2352 by 1568 pixels. Retinal fundus photograph
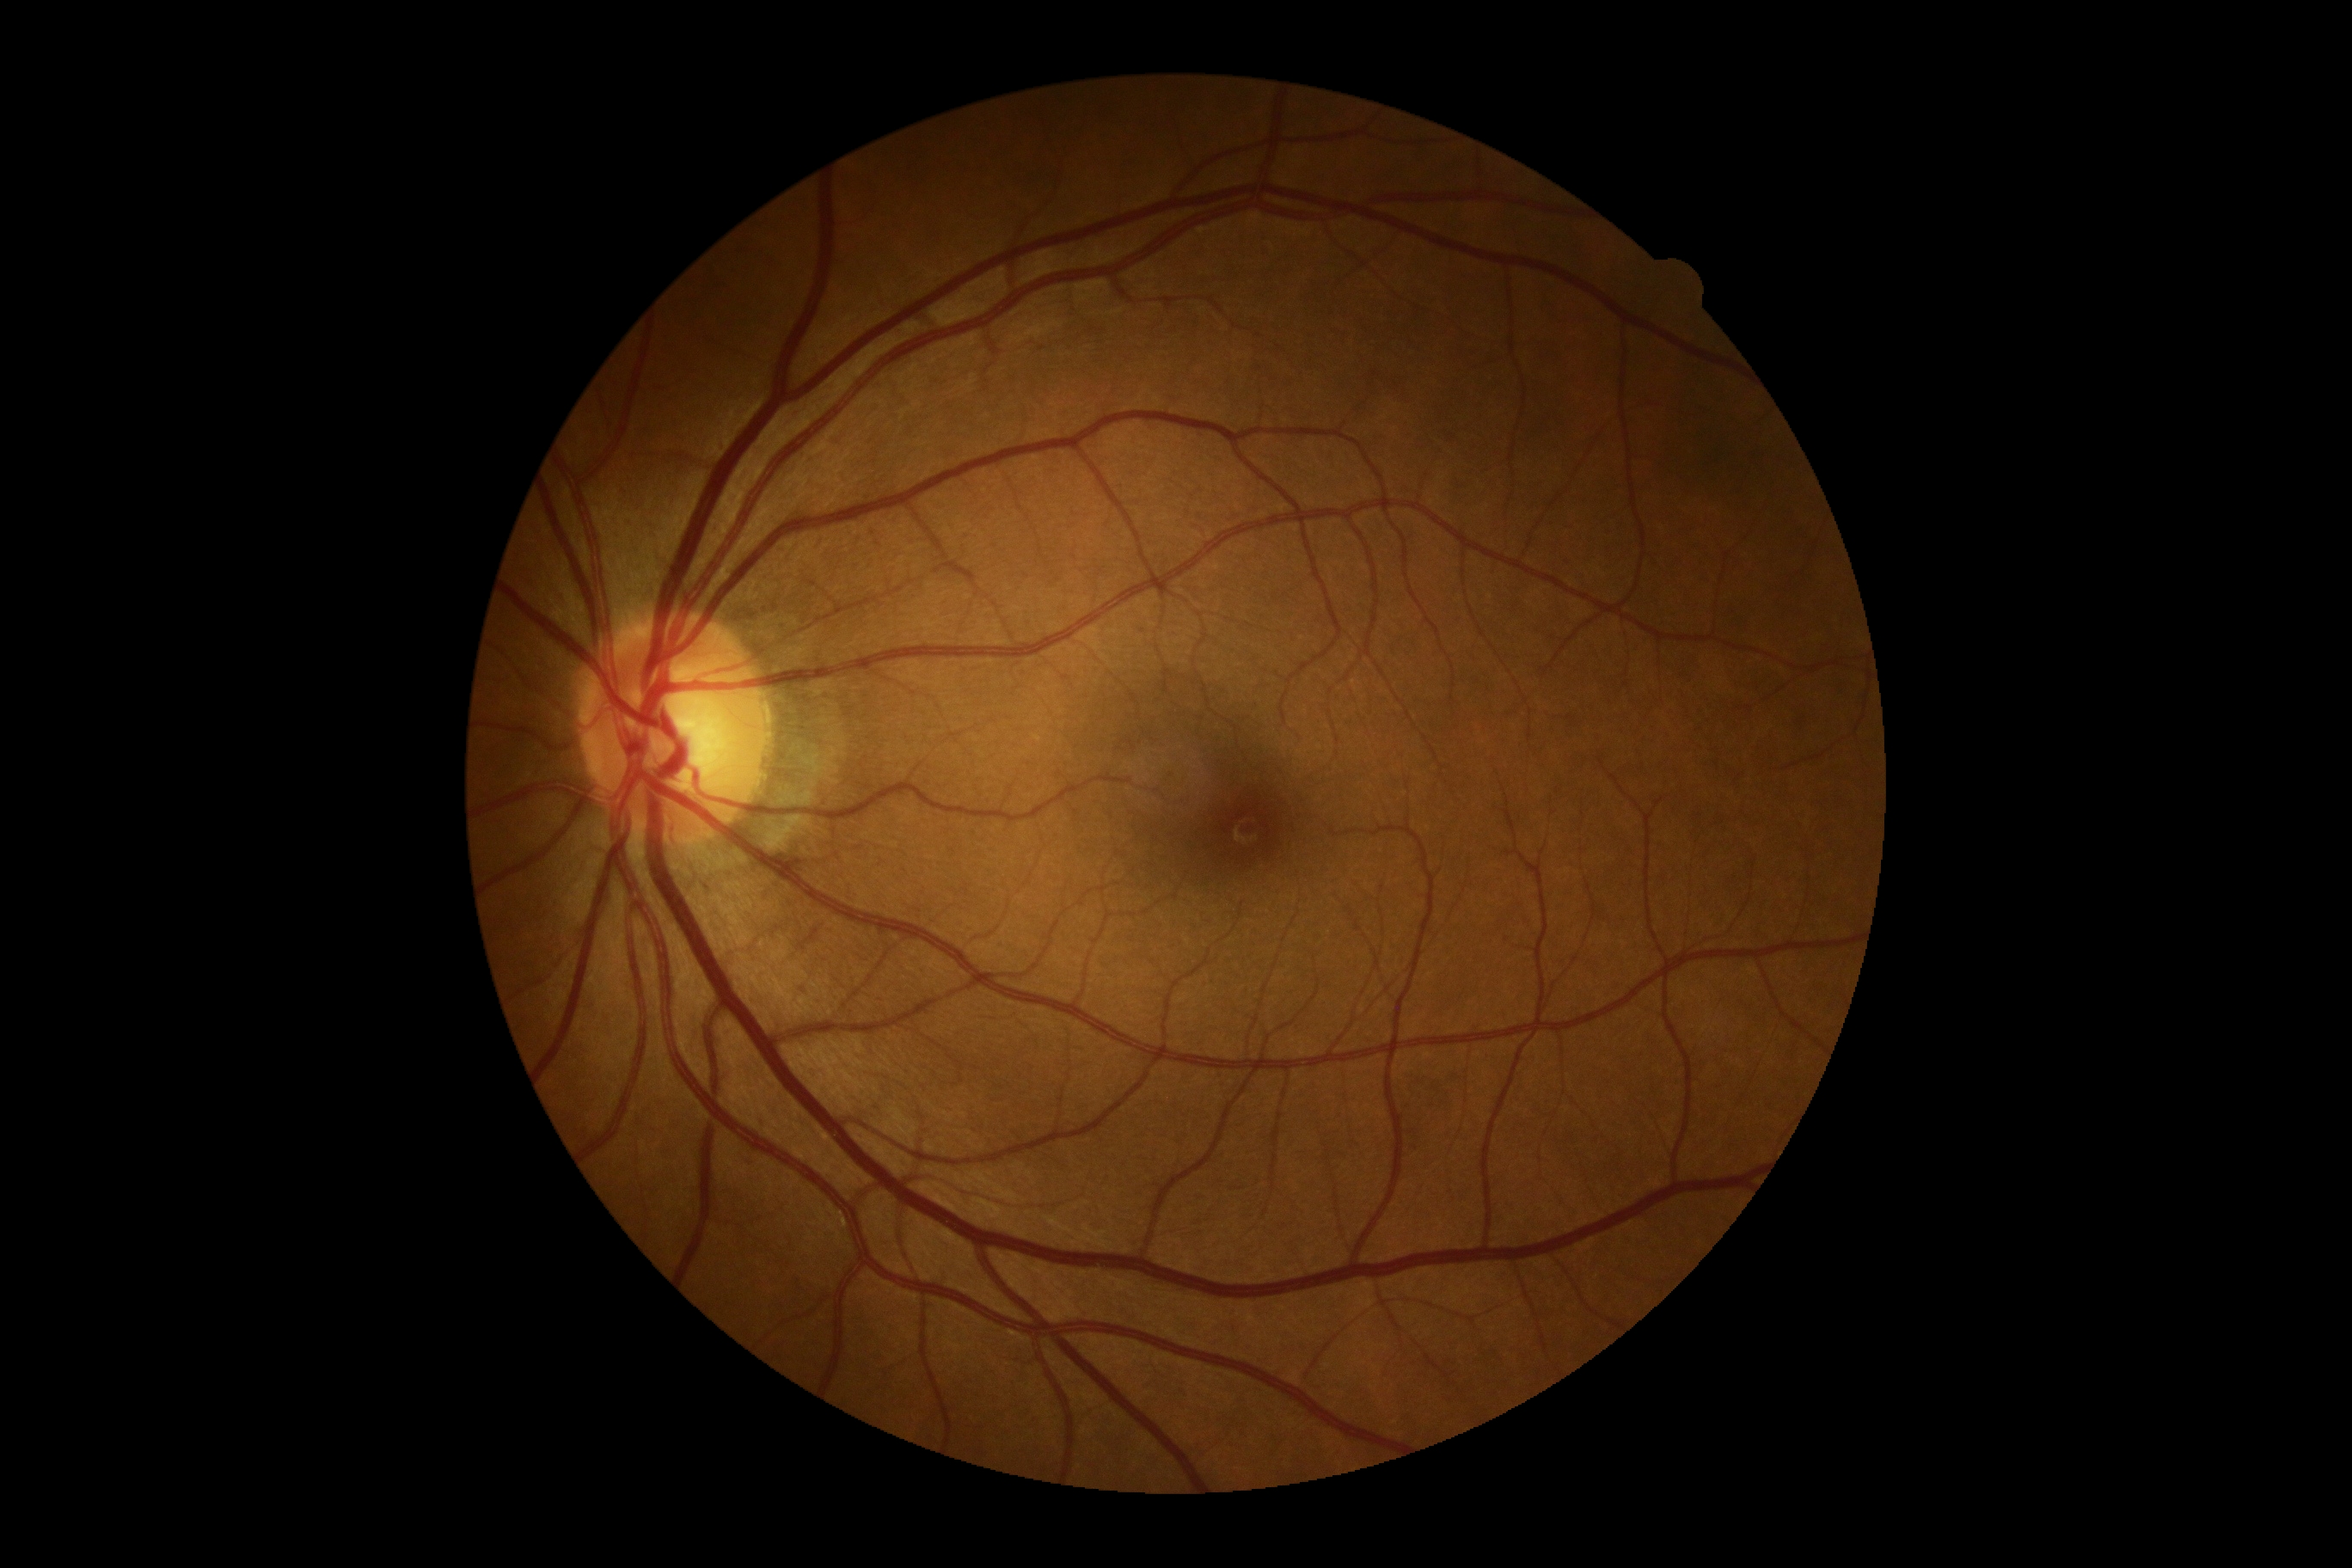

No DR findings. DR severity is no apparent diabetic retinopathy (grade 0).